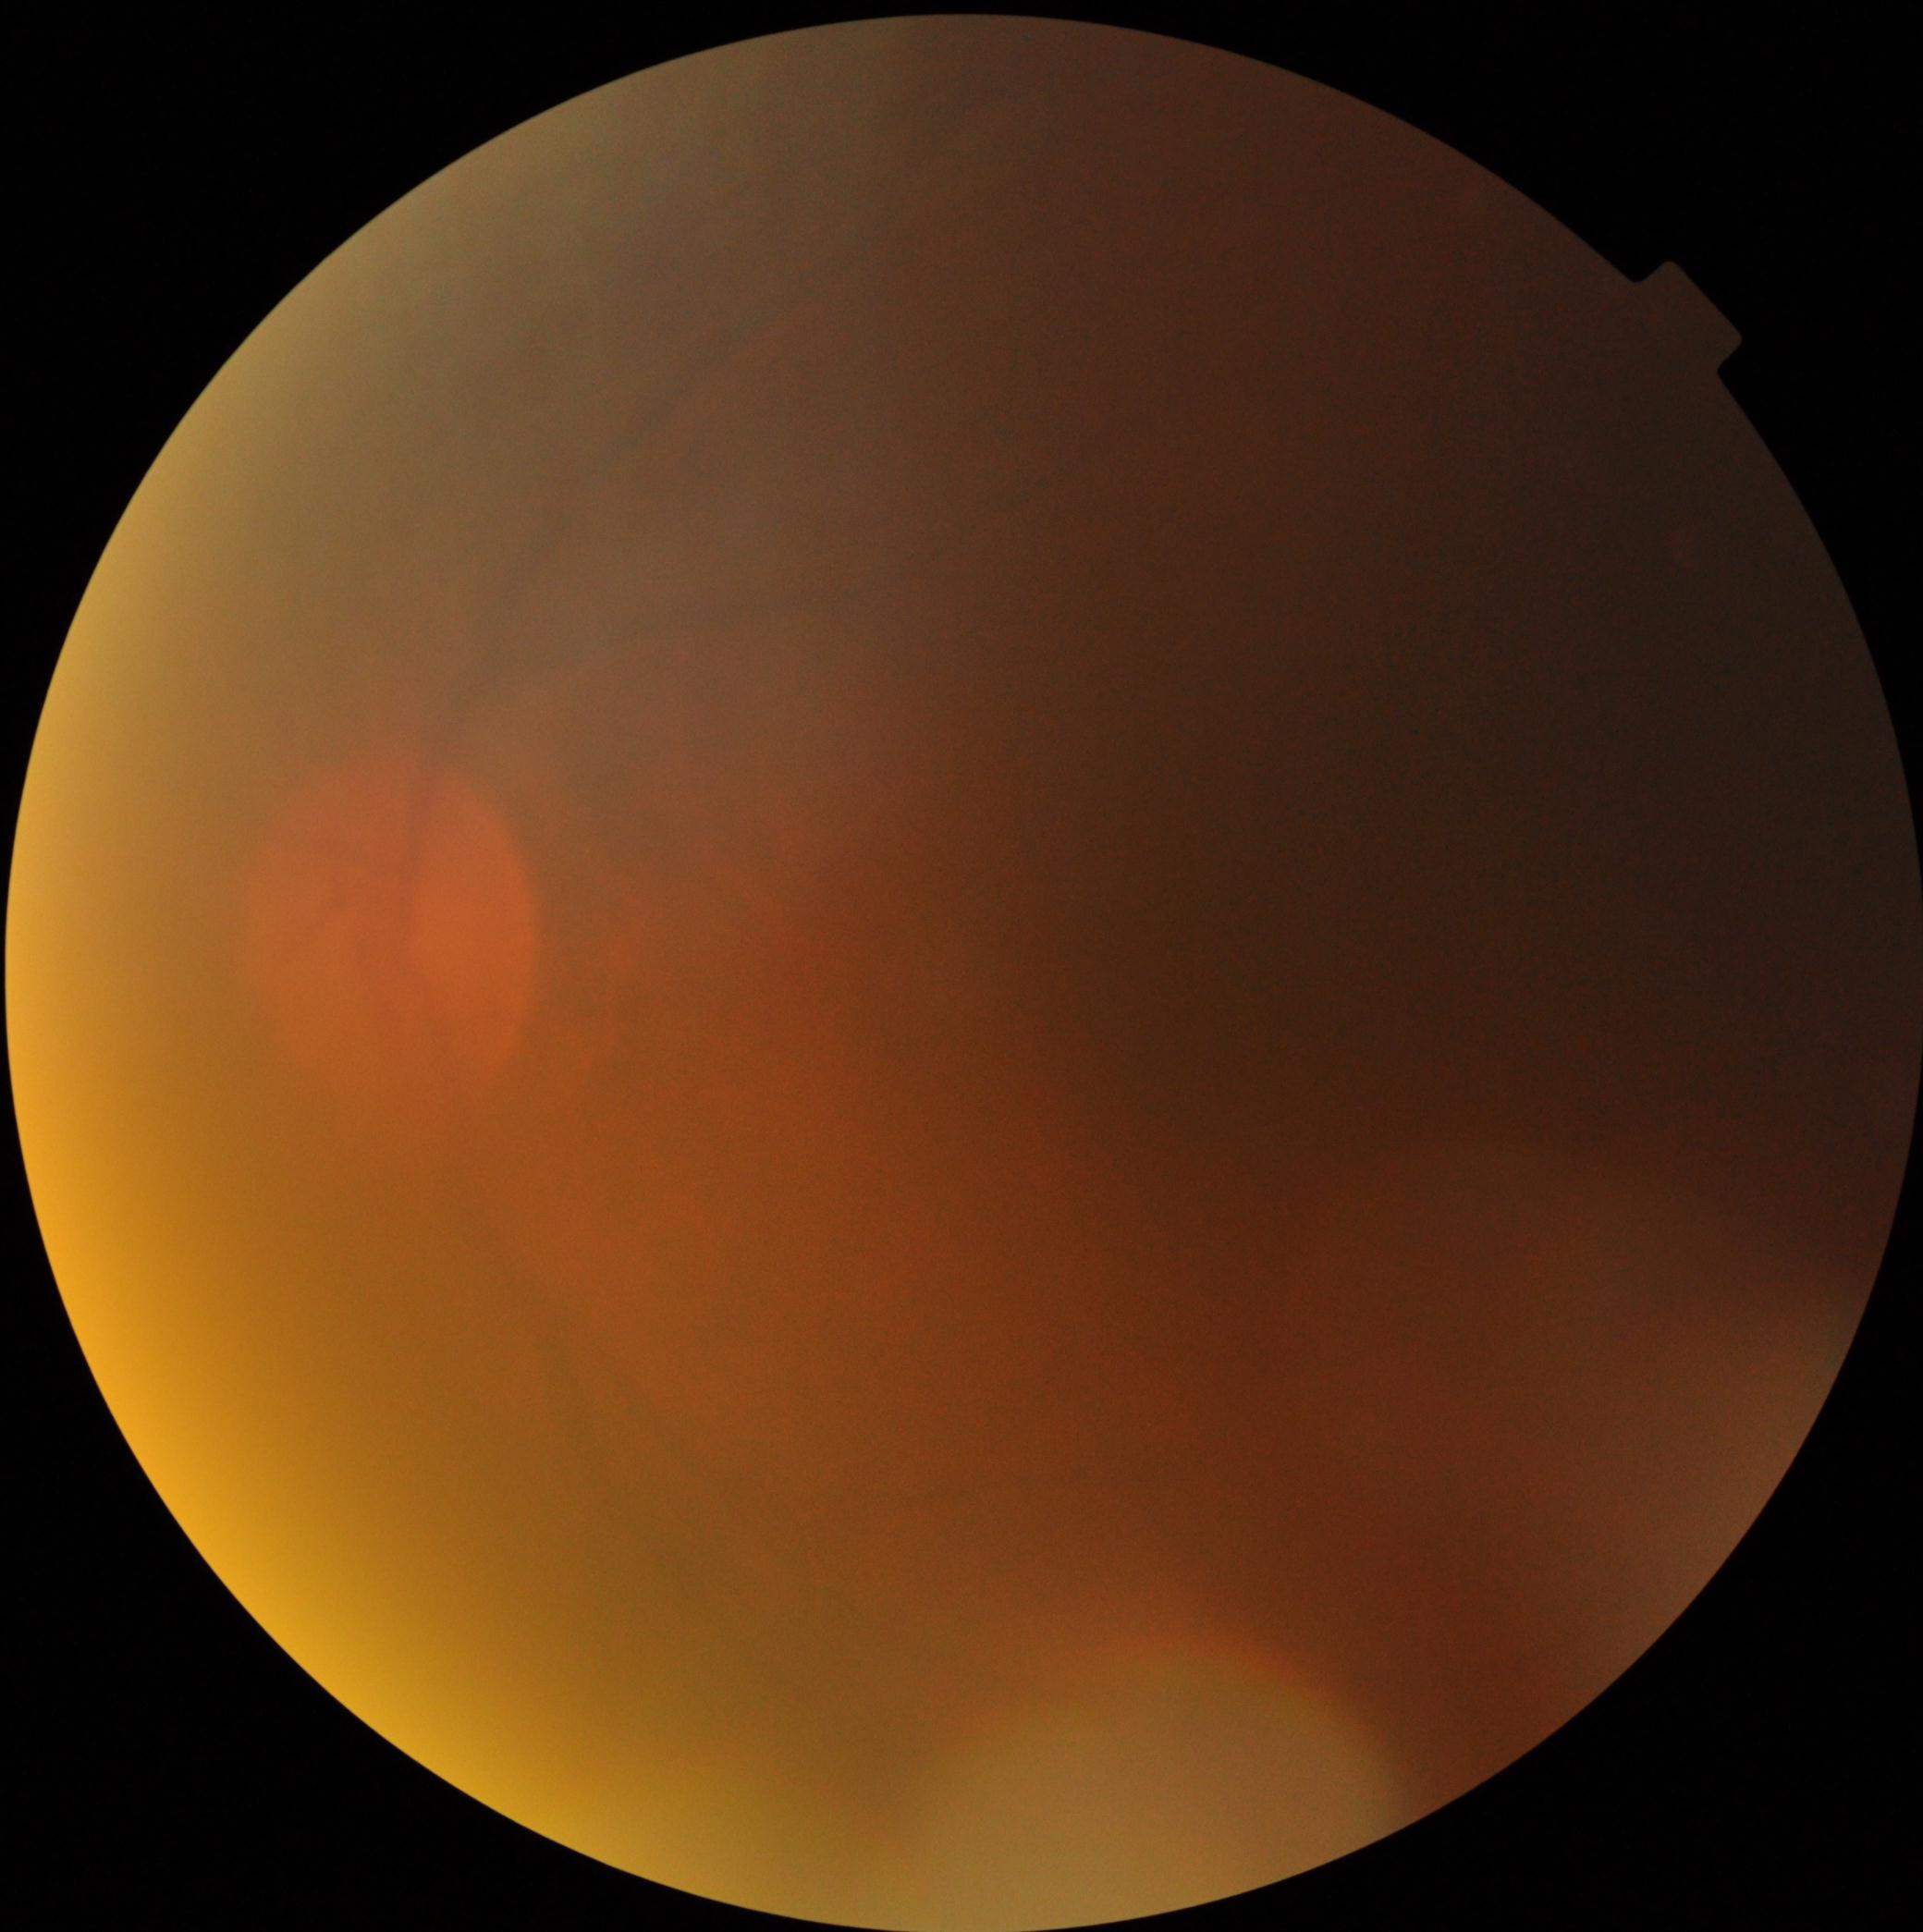
{
  "dr_grade": "ungradable due to poor image quality"
}